Camera: NIDEK AFC-230 · without pupil dilation · 848 x 848 pixels · graded on the modified Davis scale · color fundus photograph — 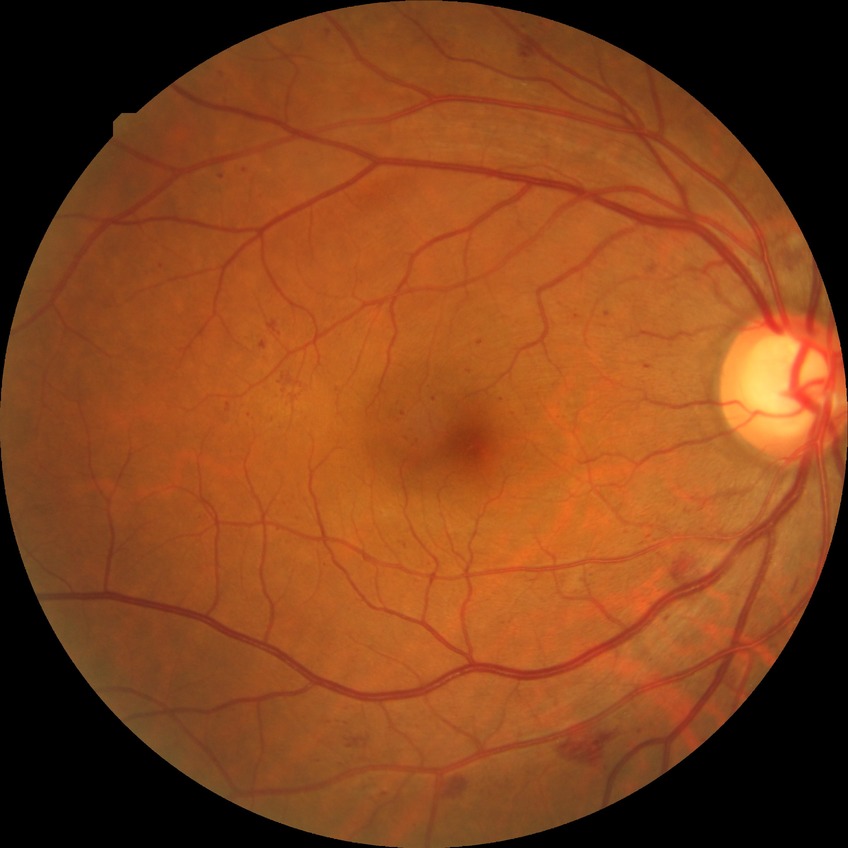

Davis grading is simple diabetic retinopathy.